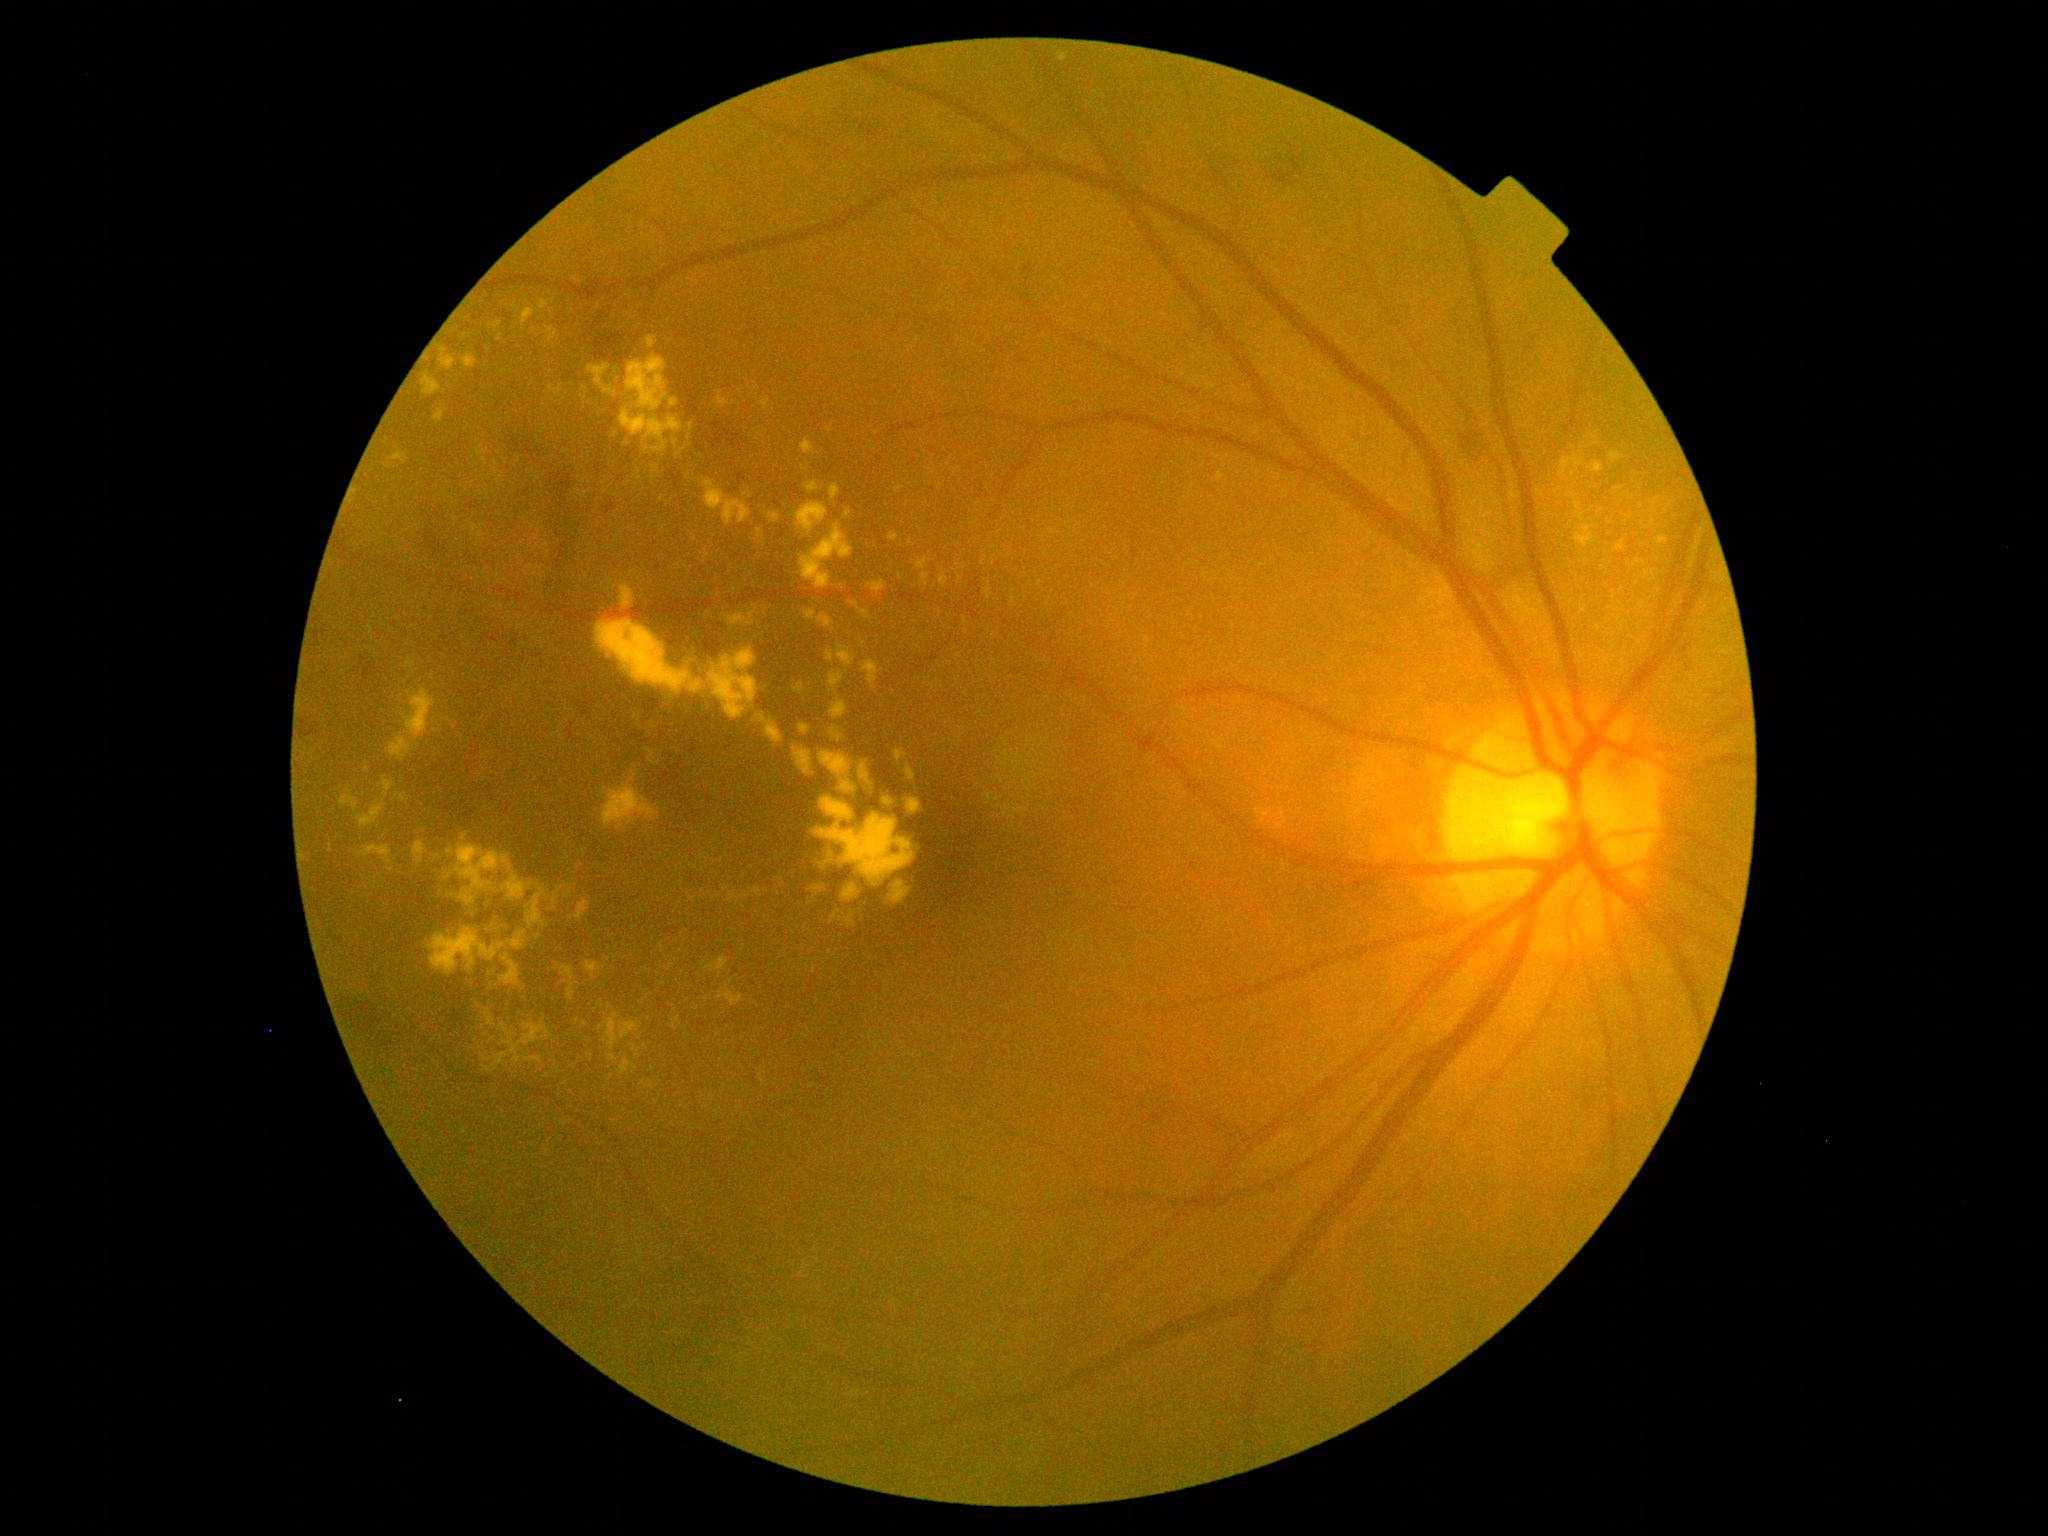

DR severity is moderate NPDR (grade 2).